1932x1932px, retinal fundus photograph, FOV: 45 degrees — 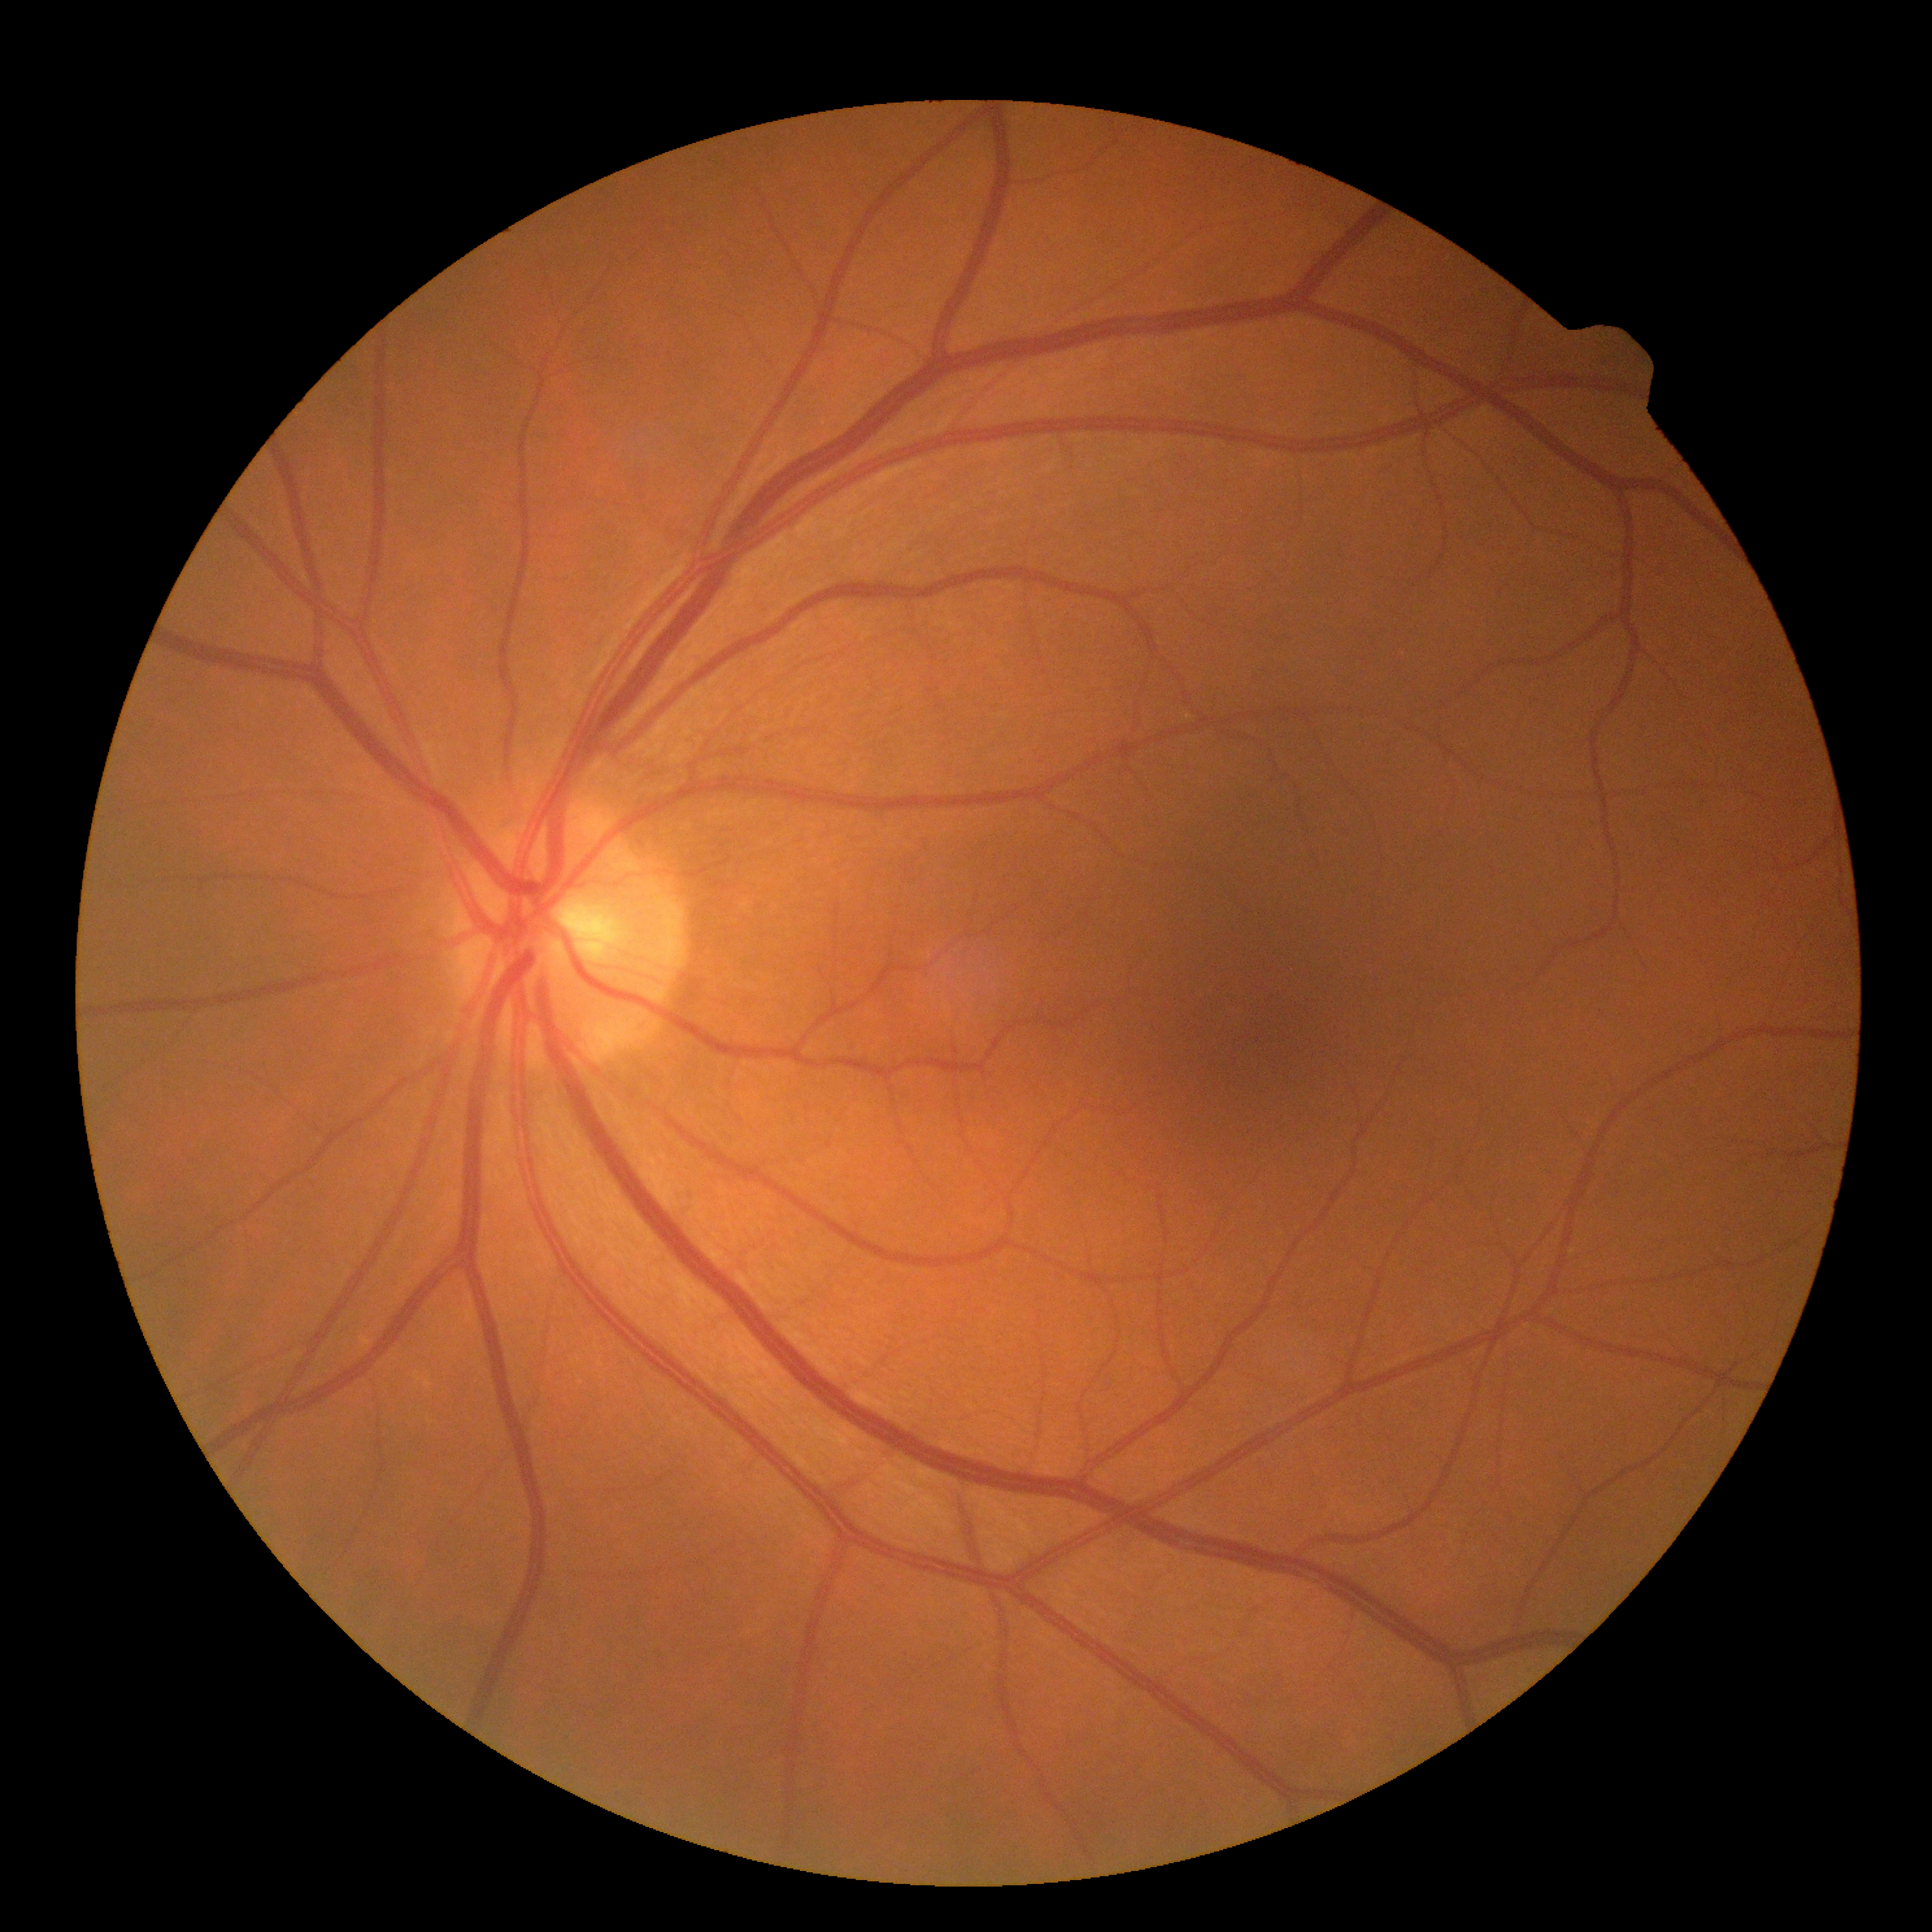

DR stage is grade 0.